Fundus photo; modified Davis classification — 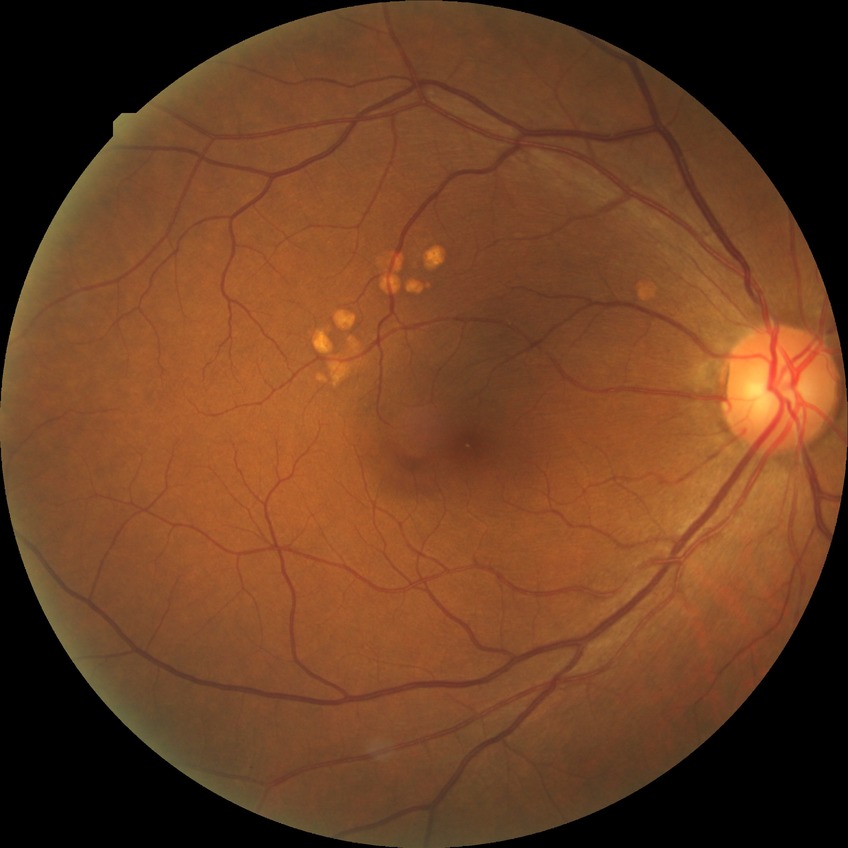

- diabetic retinopathy (DR): NDR (no diabetic retinopathy)